Image size 2212x1659
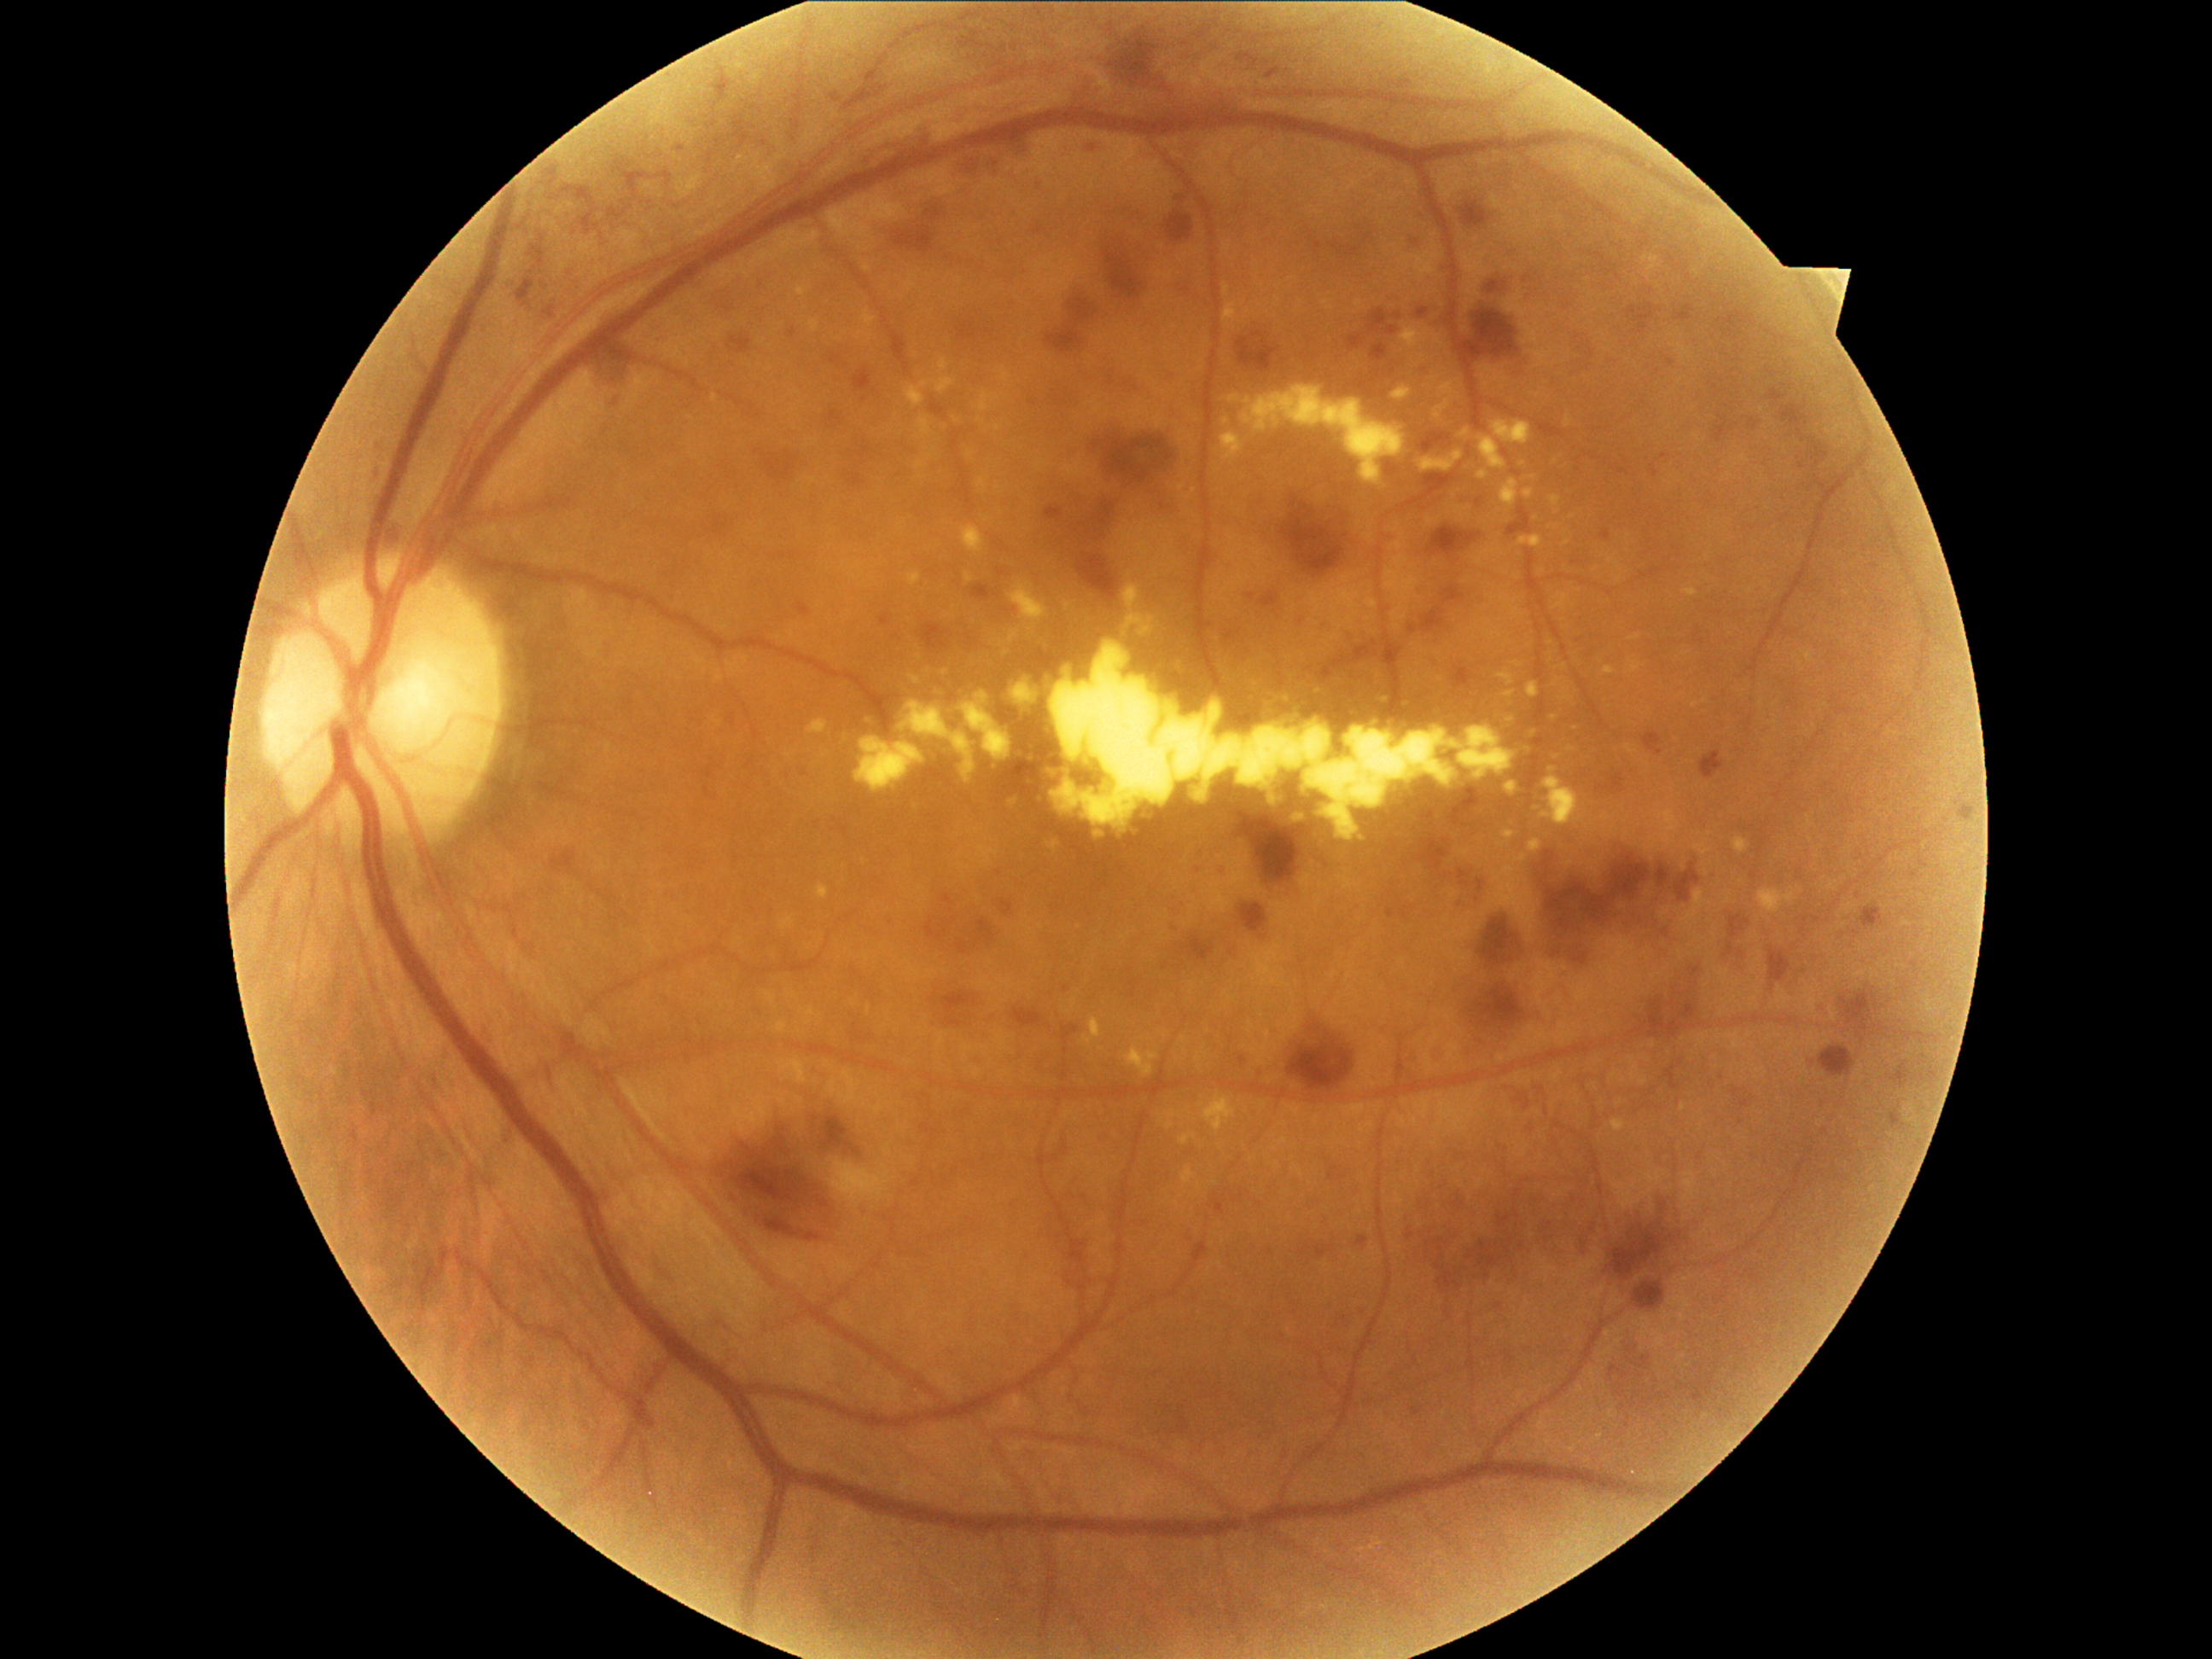
DR grade is 3/4
Selected lesions:
• EXs (subset): box(1402, 390, 1417, 404) | box(1380, 697, 1390, 702) | box(1540, 776, 1585, 827) | box(967, 527, 986, 547) | box(1684, 588, 1697, 598) | box(1010, 680, 1045, 711) | box(808, 719, 829, 733) | box(1223, 385, 1407, 484) | box(1551, 498, 1561, 506) | box(1501, 479, 1520, 508) | box(1612, 1121, 1627, 1132) | box(1424, 453, 1464, 474) | box(907, 571, 921, 588)
• Small EXs near point(1536, 518)
• HEs (subset): box(552, 849, 576, 873) | box(992, 562, 1008, 574) | box(721, 1114, 861, 1243) | box(1394, 313, 1402, 322) | box(1440, 789, 1482, 830) | box(1429, 523, 1484, 550) | box(1610, 1341, 1651, 1426) | box(1674, 305, 1696, 323) | box(1486, 281, 1508, 296) | box(1633, 1279, 1665, 1310) | box(1109, 35, 1163, 90) | box(902, 129, 936, 154) | box(853, 364, 878, 397) | box(1027, 393, 1039, 405) | box(1452, 1197, 1467, 1213) | box(1713, 422, 1728, 443)
• Small HEs near point(988, 946) | point(1069, 277)